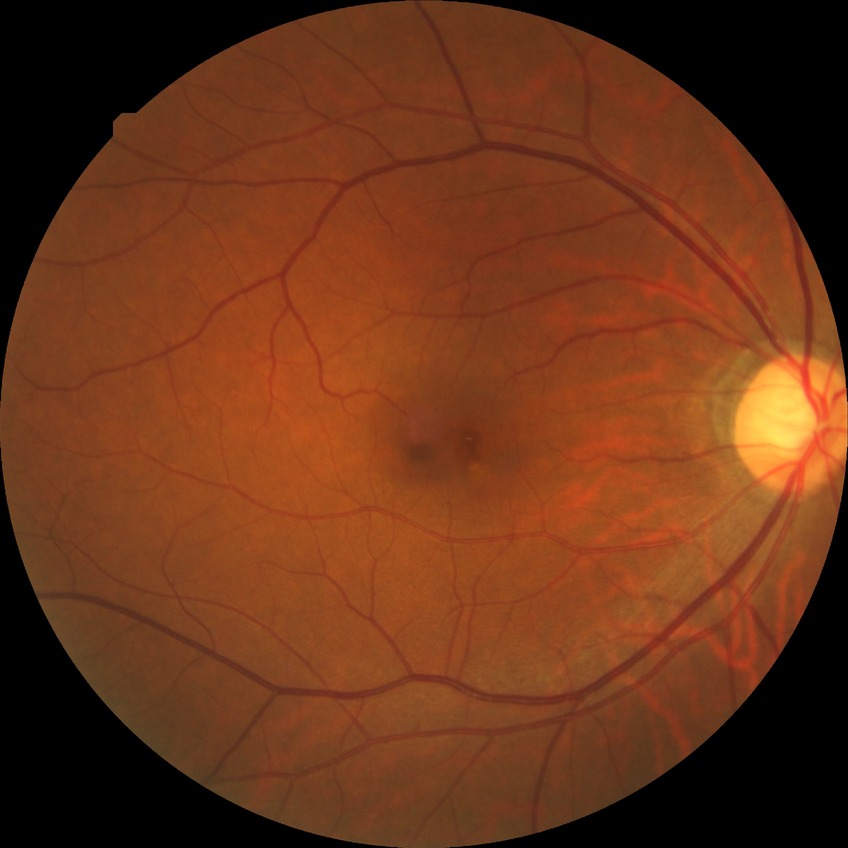

Davis DR grade is NDR.